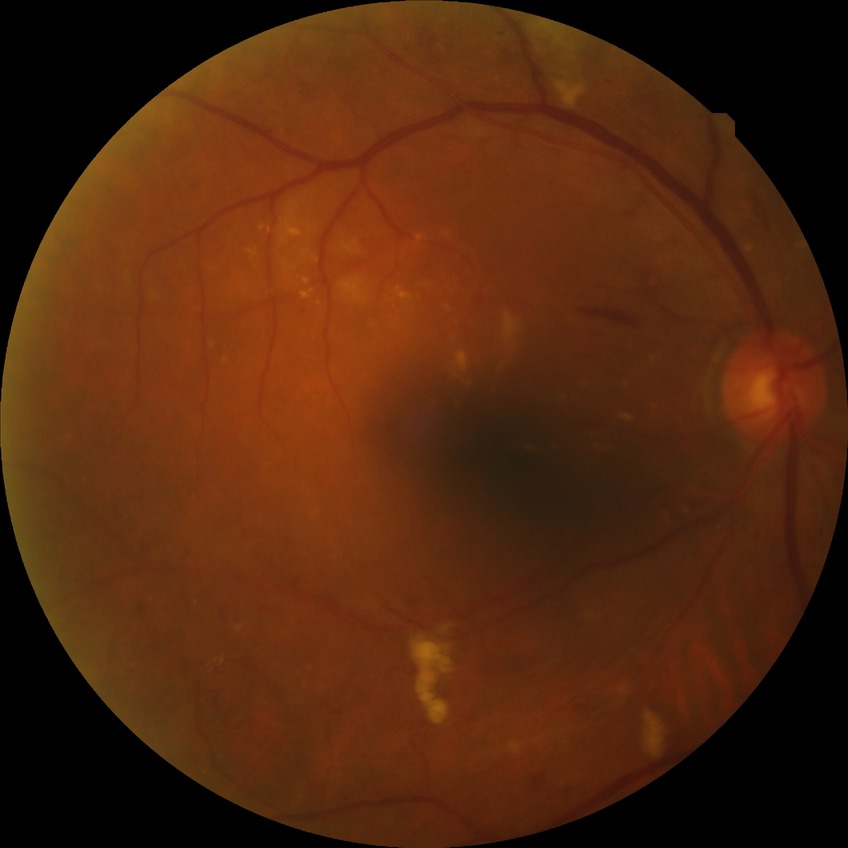 Modified Davis classification: pre-proliferative diabetic retinopathy.